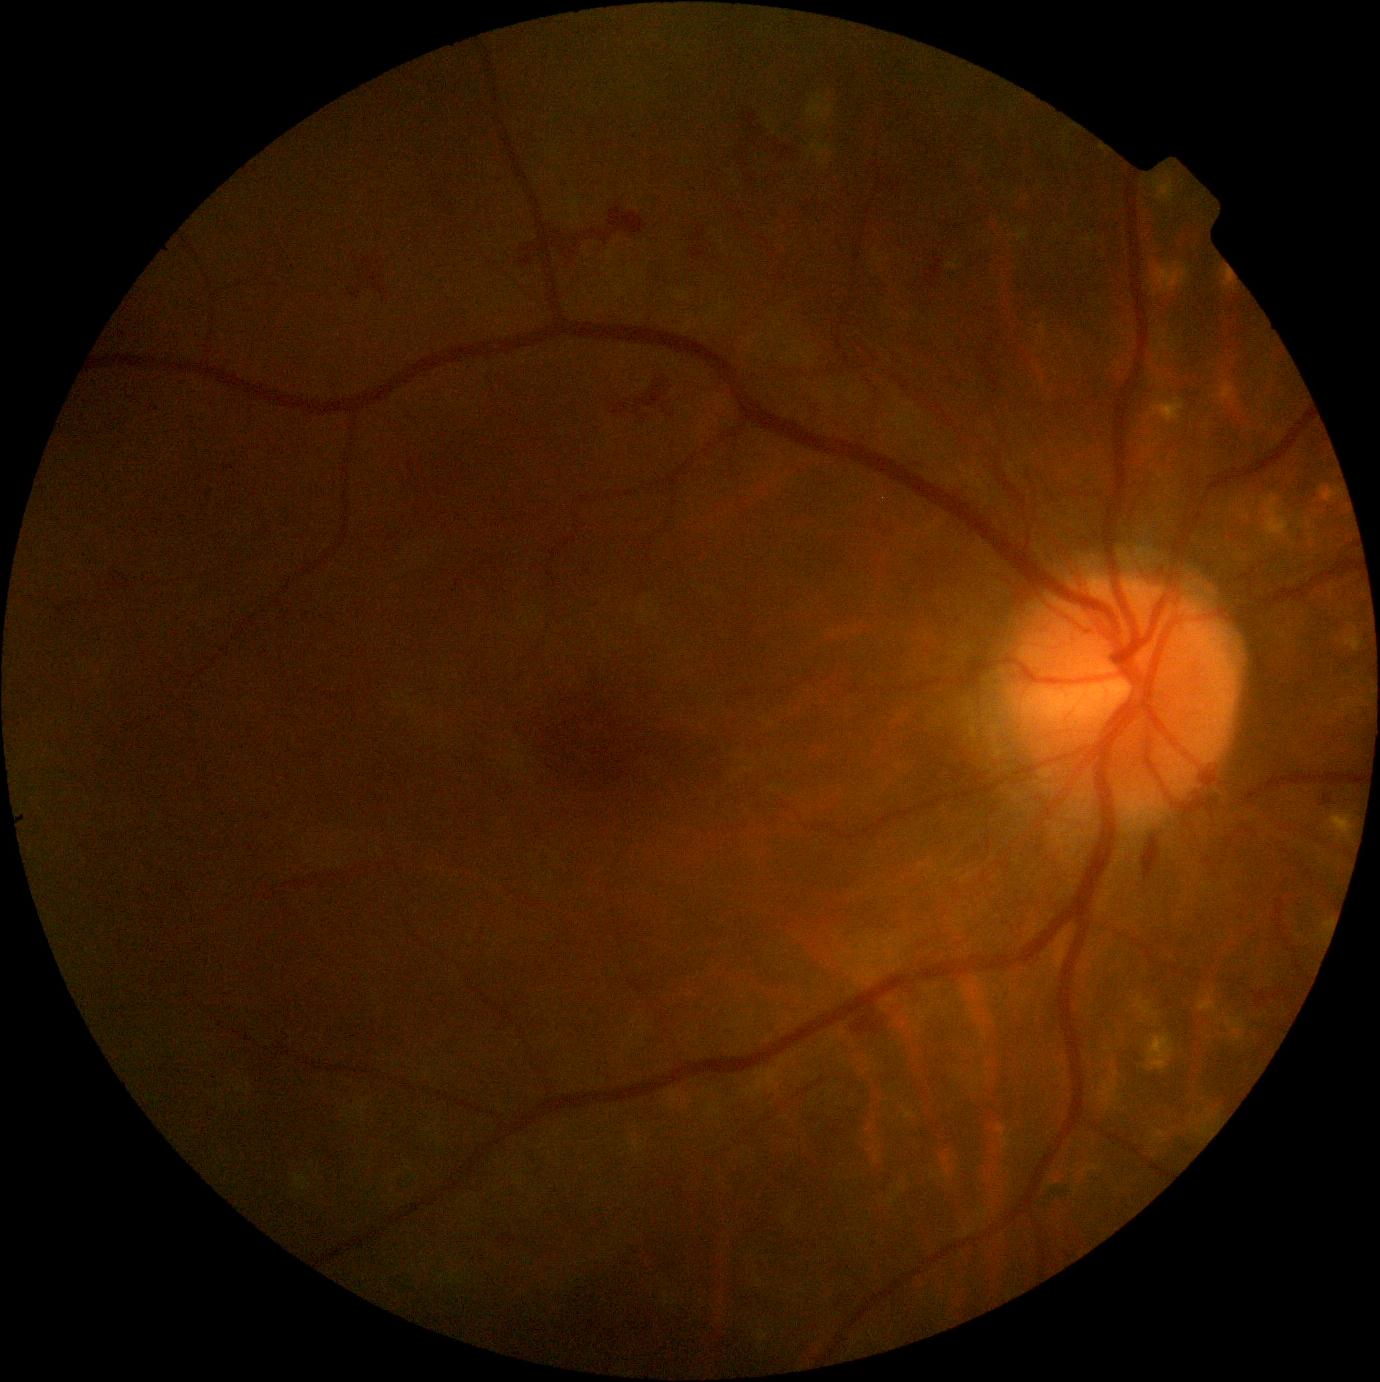
Disease class: non-proliferative diabetic retinopathy.
Diabetic retinopathy is 2/4.